Color fundus image, FOV: 45 degrees, 848 by 848 pixels, modified Davis grading.
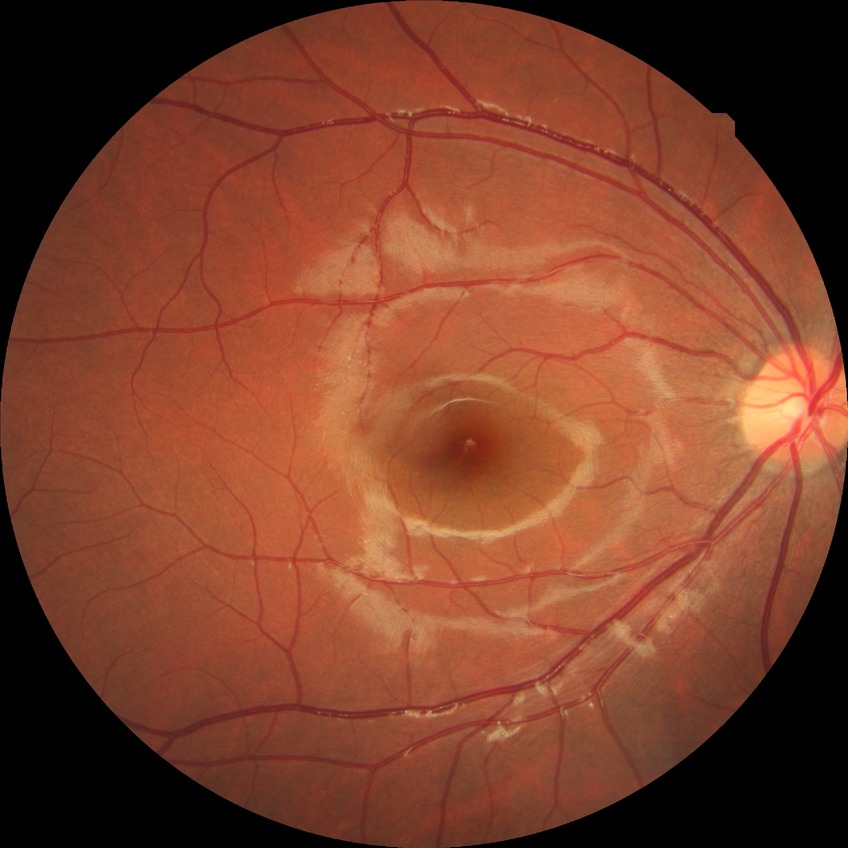 Diabetic retinopathy (DR) is no diabetic retinopathy (NDR).